CFP — 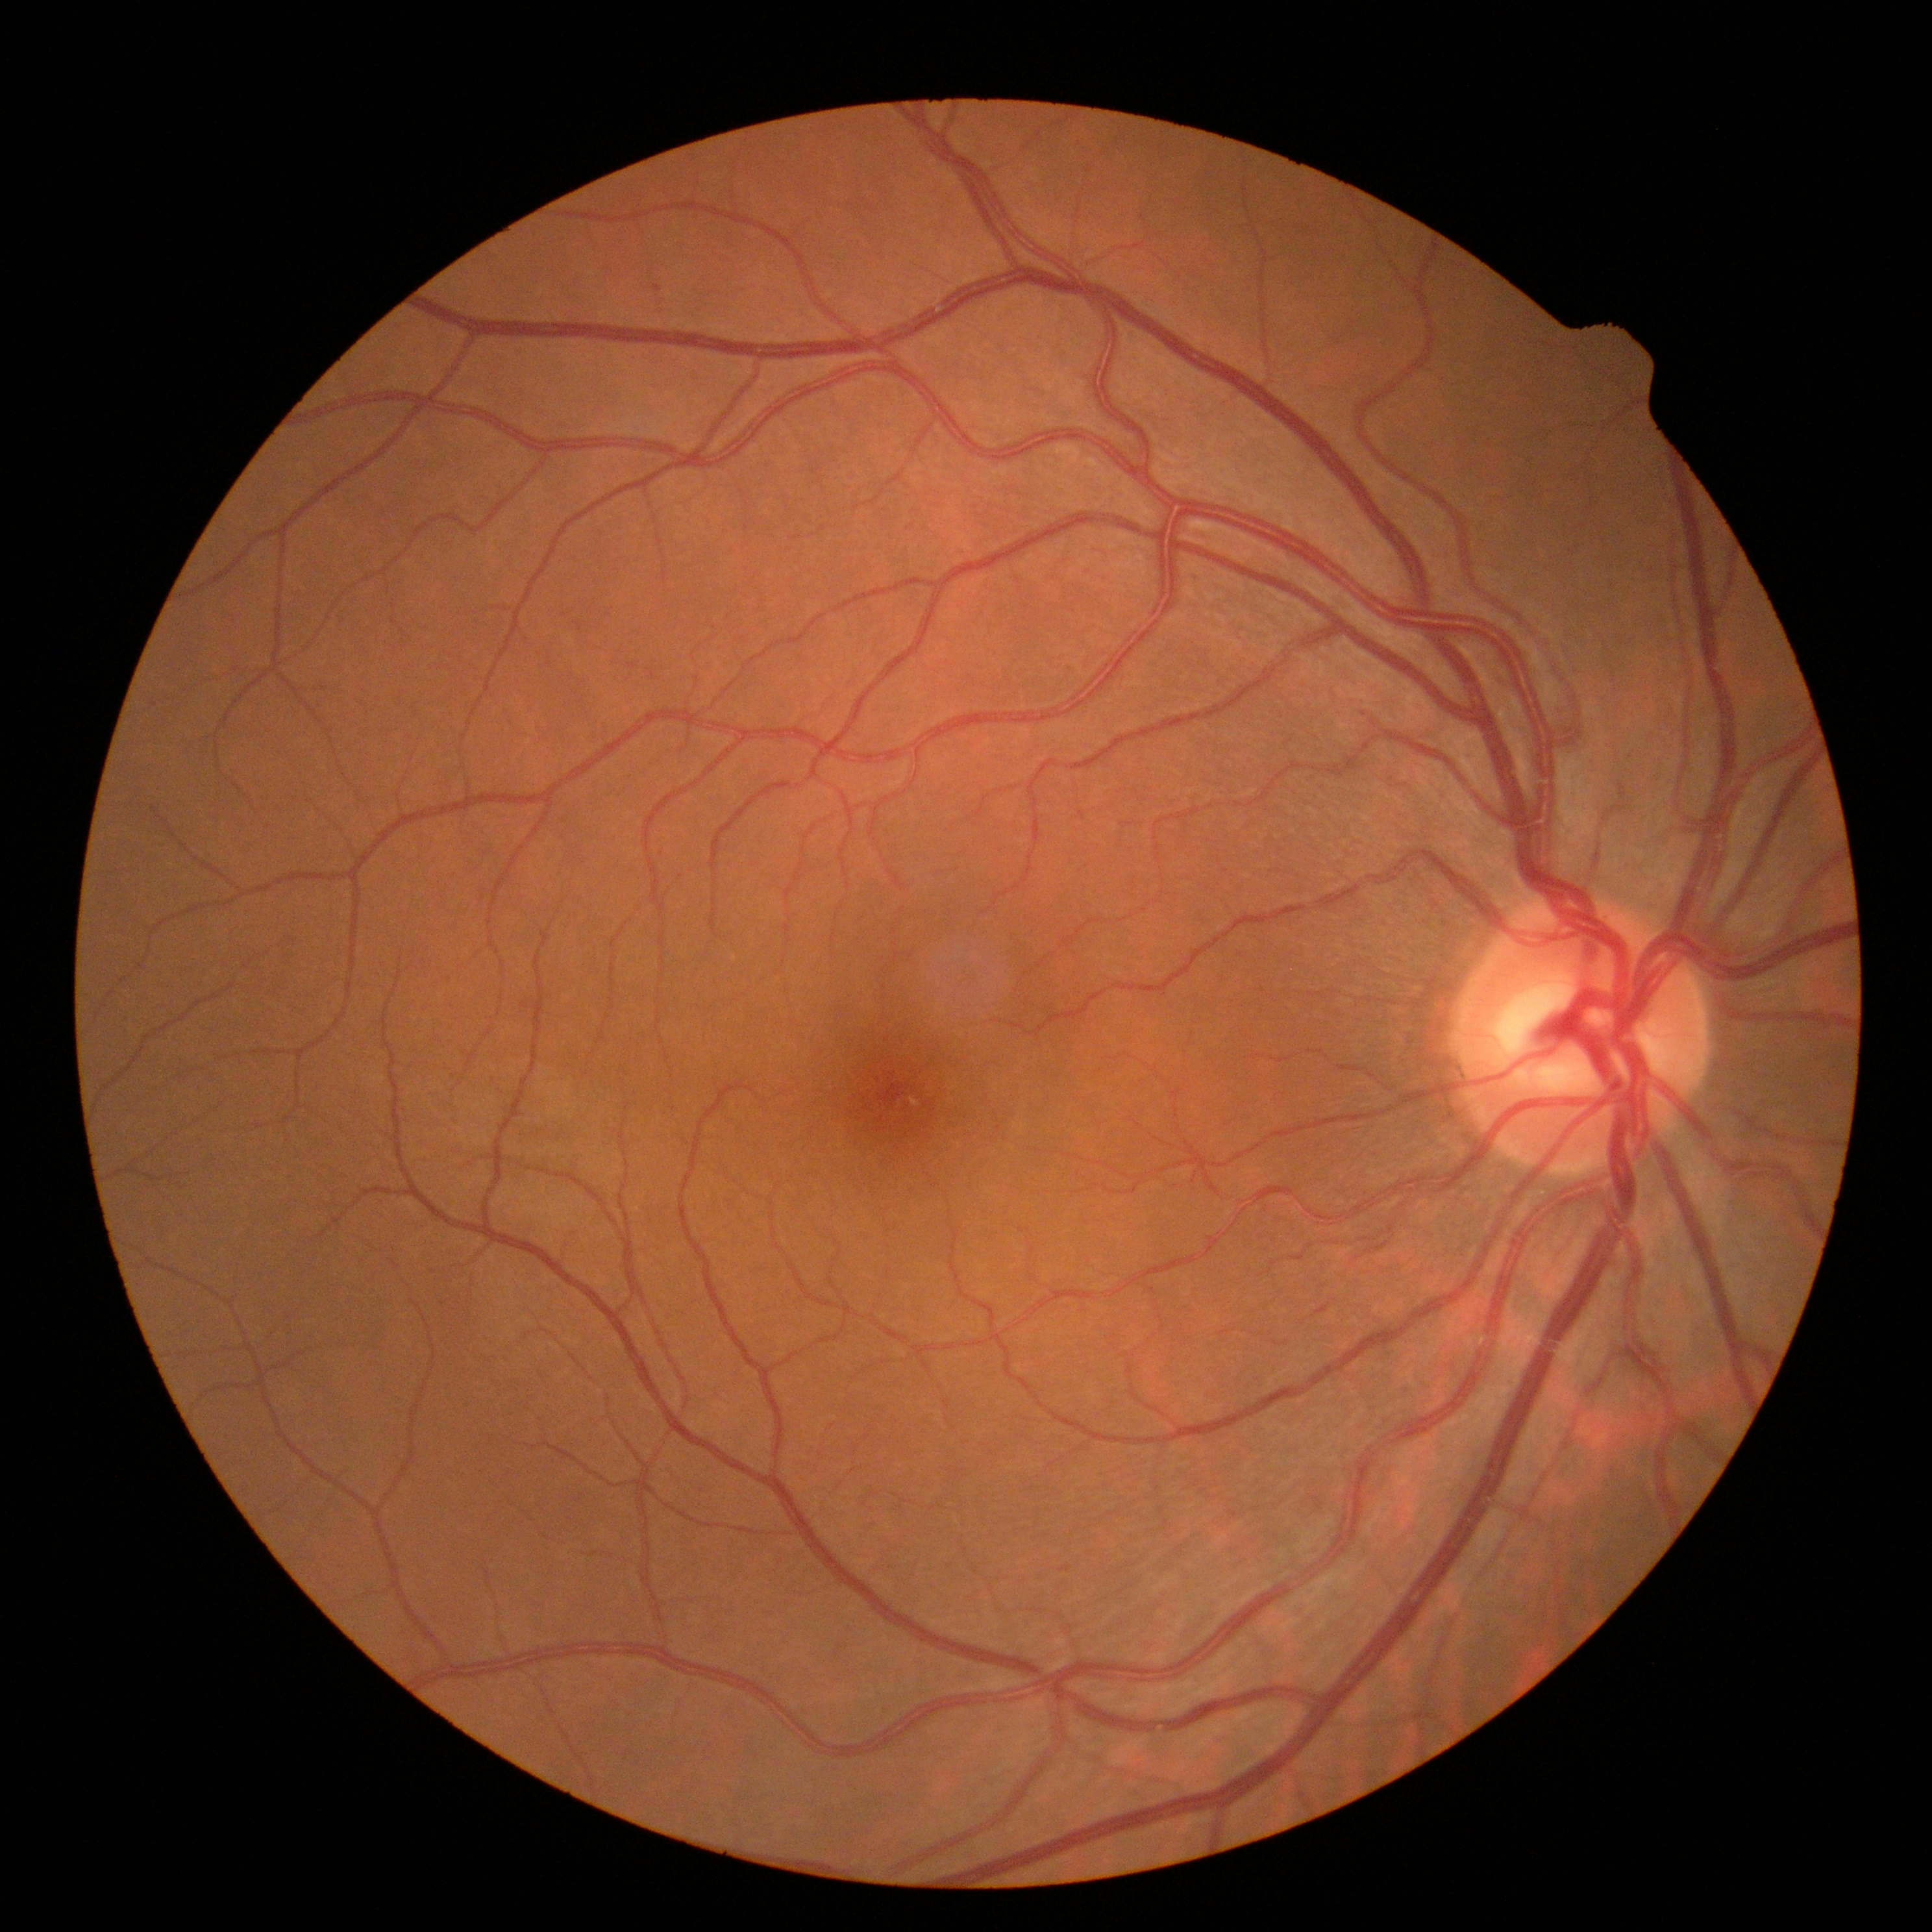
Diabetic retinopathy (DR) is grade 0 (no apparent retinopathy).